640 by 480 pixels. RetCam wide-field infant fundus image — 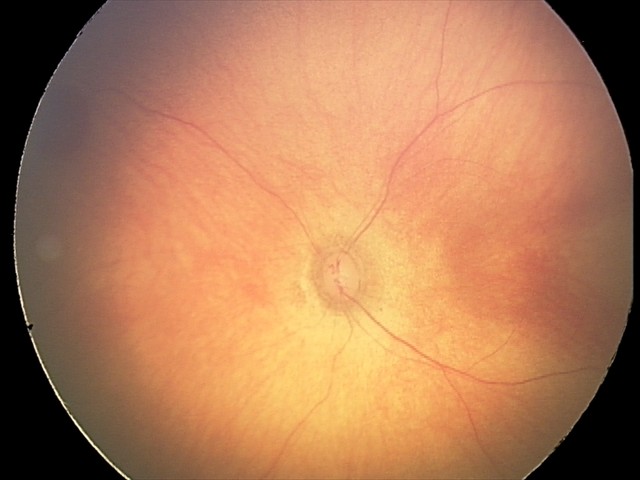

Screening diagnosis: retinal hemorrhages.